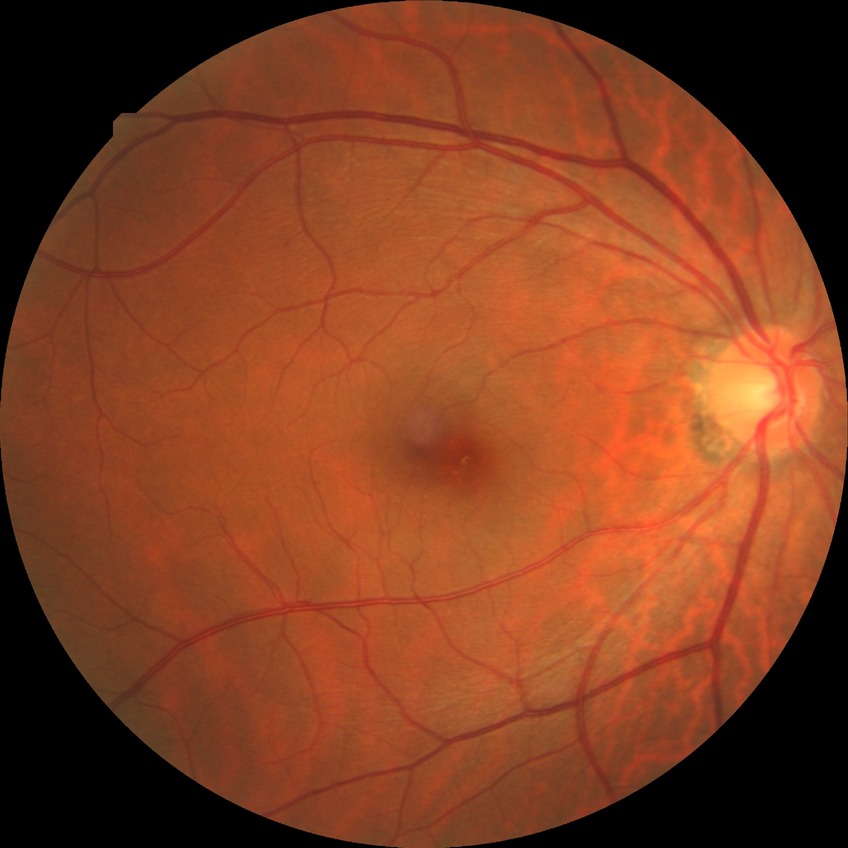
Diabetic retinopathy (DR): NDR (no diabetic retinopathy).